Image size 2346x1568 · color fundus image · 45-degree field of view — 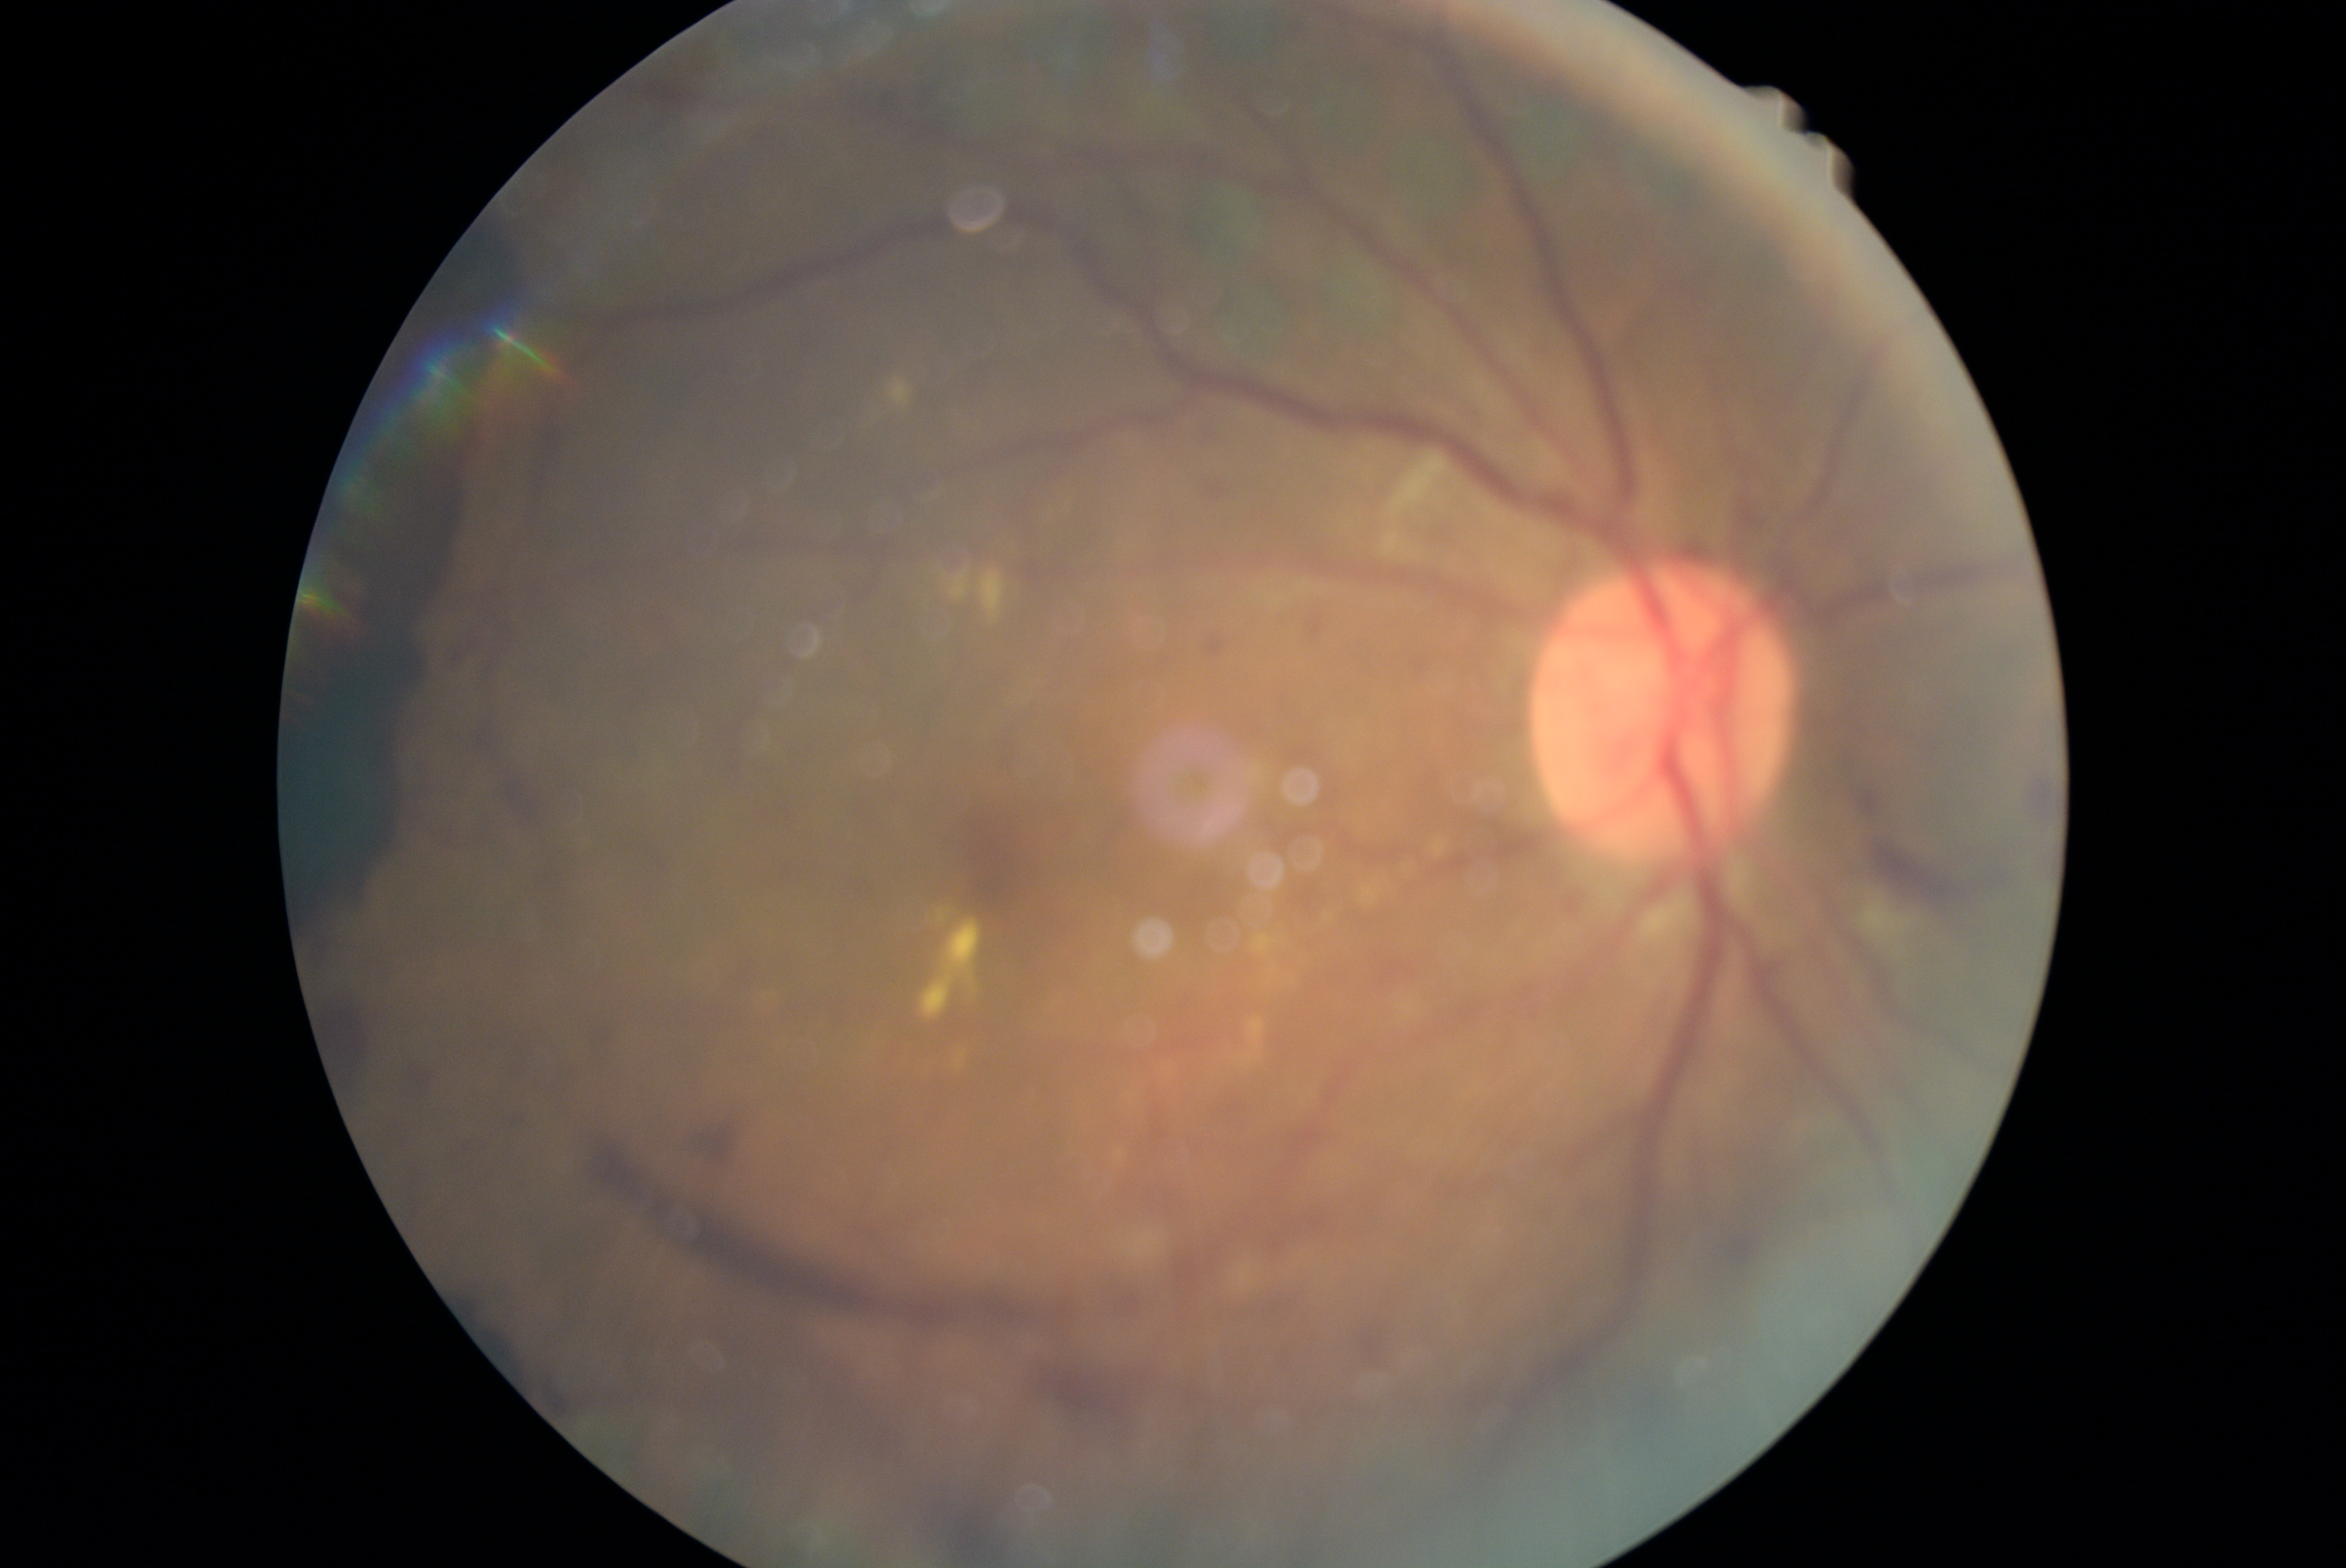 - retinopathy grade: proliferative diabetic retinopathy (4)